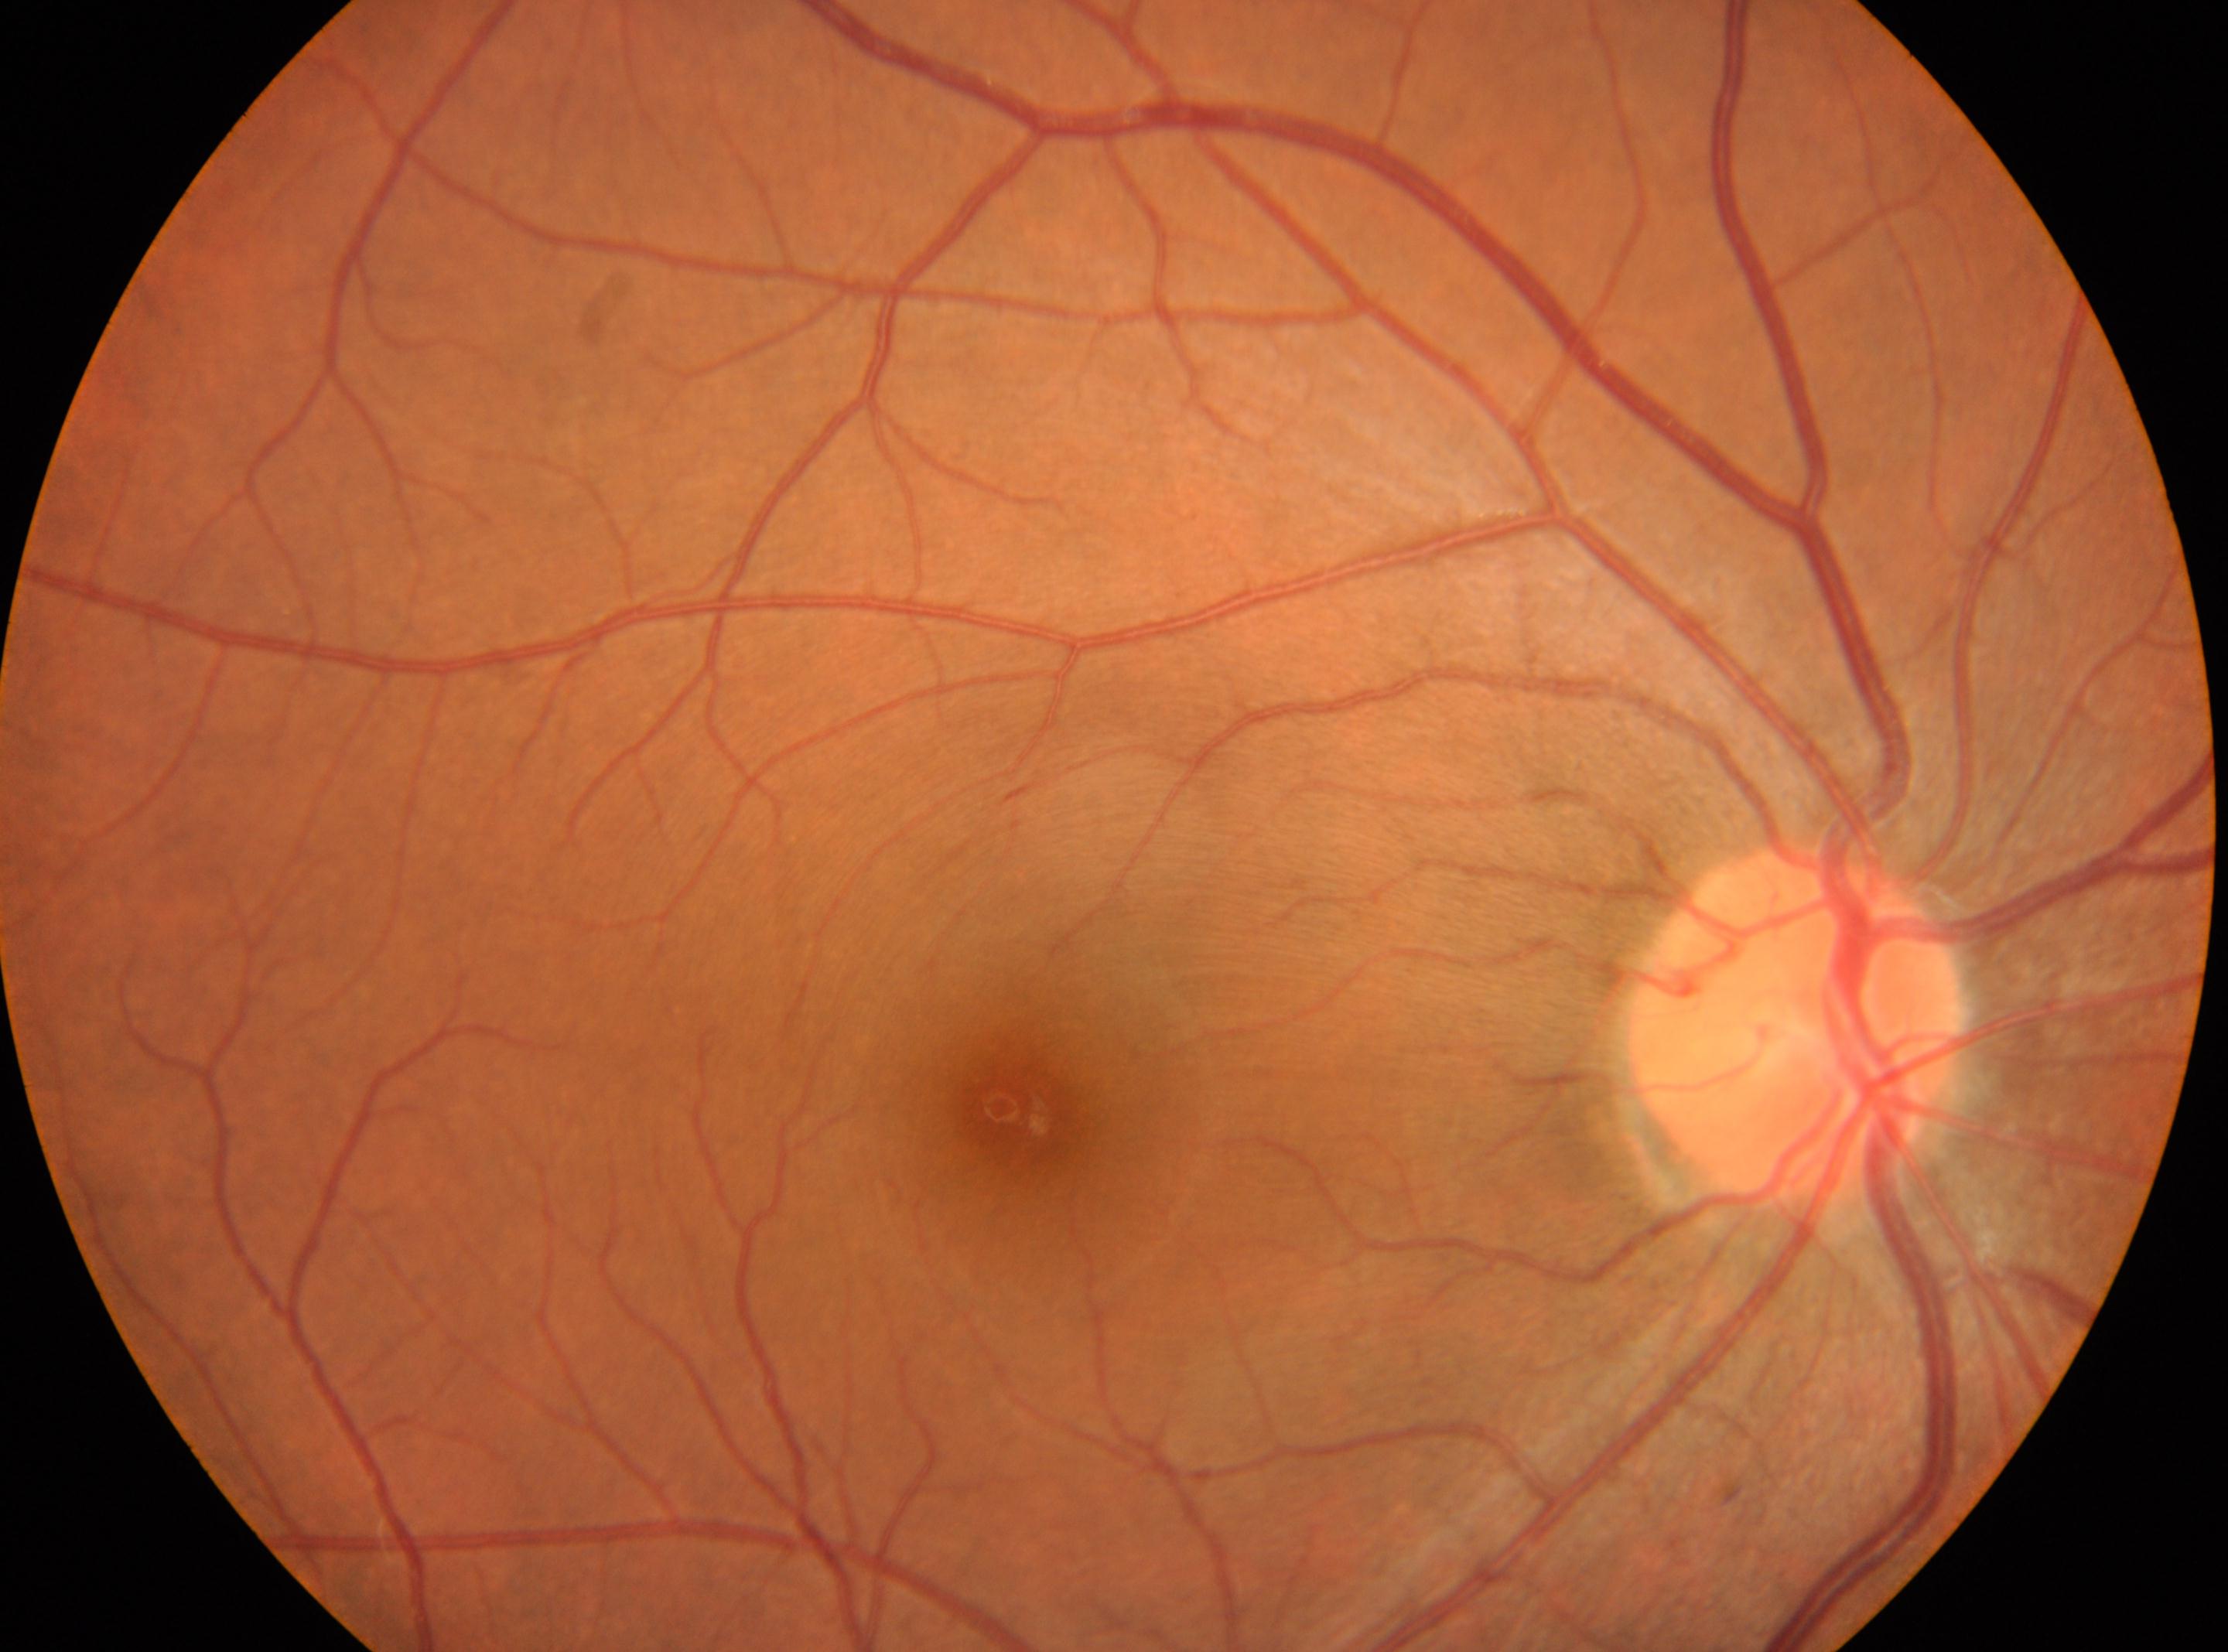 Findings:
• diabetic retinopathy: 0/4
• optic disk: (x: 1796, y: 1026)
• macula center: (x: 1021, y: 1108)
• laterality: right eye